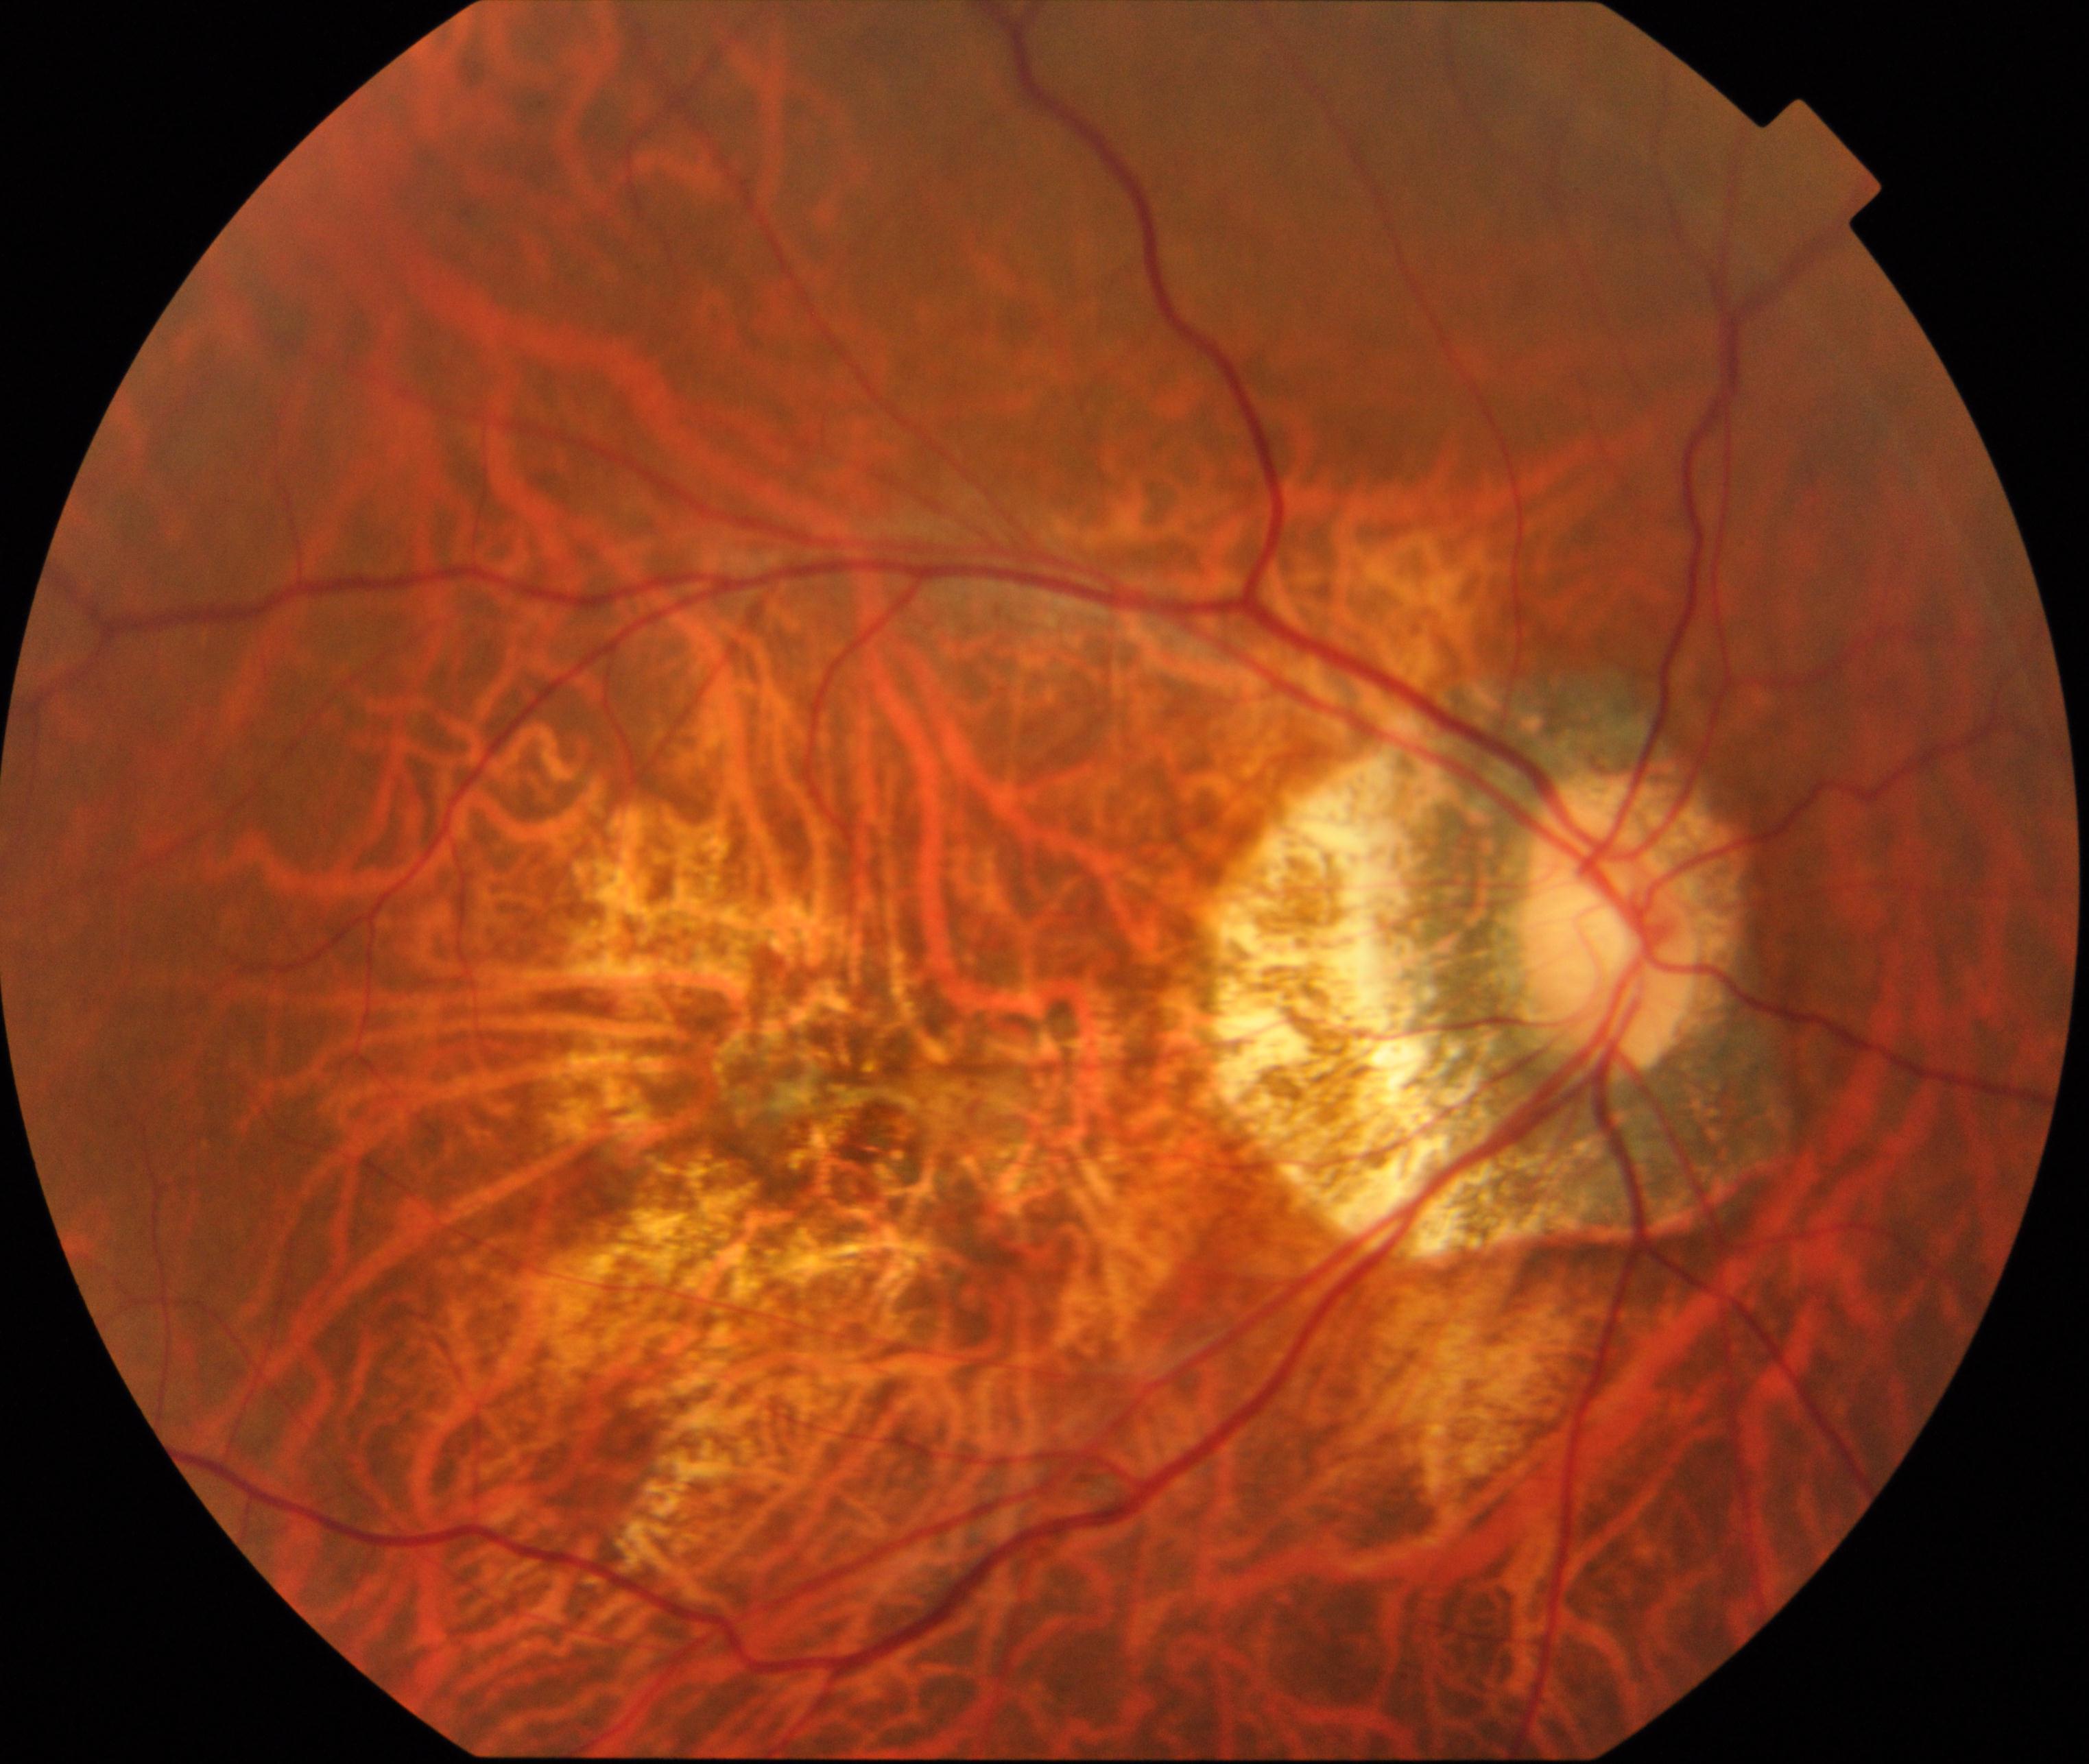 Color fundus photograph showing pathological myopia. Typically showing tessellated fundus with focal chorioretinal atrophy, Fuchs spot, lacquer cracks, choroidal neovascularization, or subretinal hemorrhage.